Wide-field fundus image from infant ROP screening — 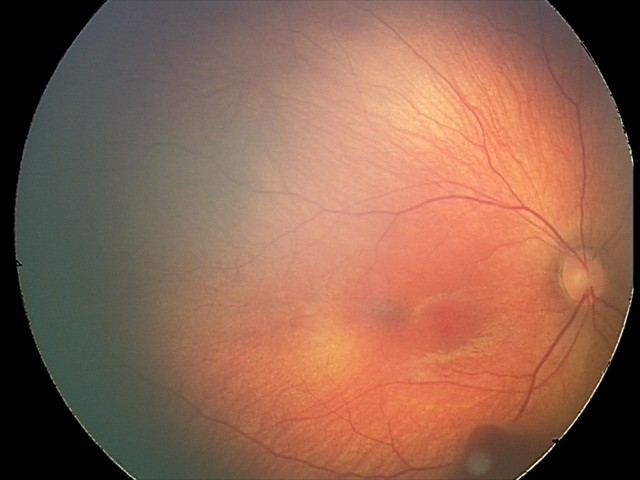
Examination diagnosed as retinal hemorrhages.